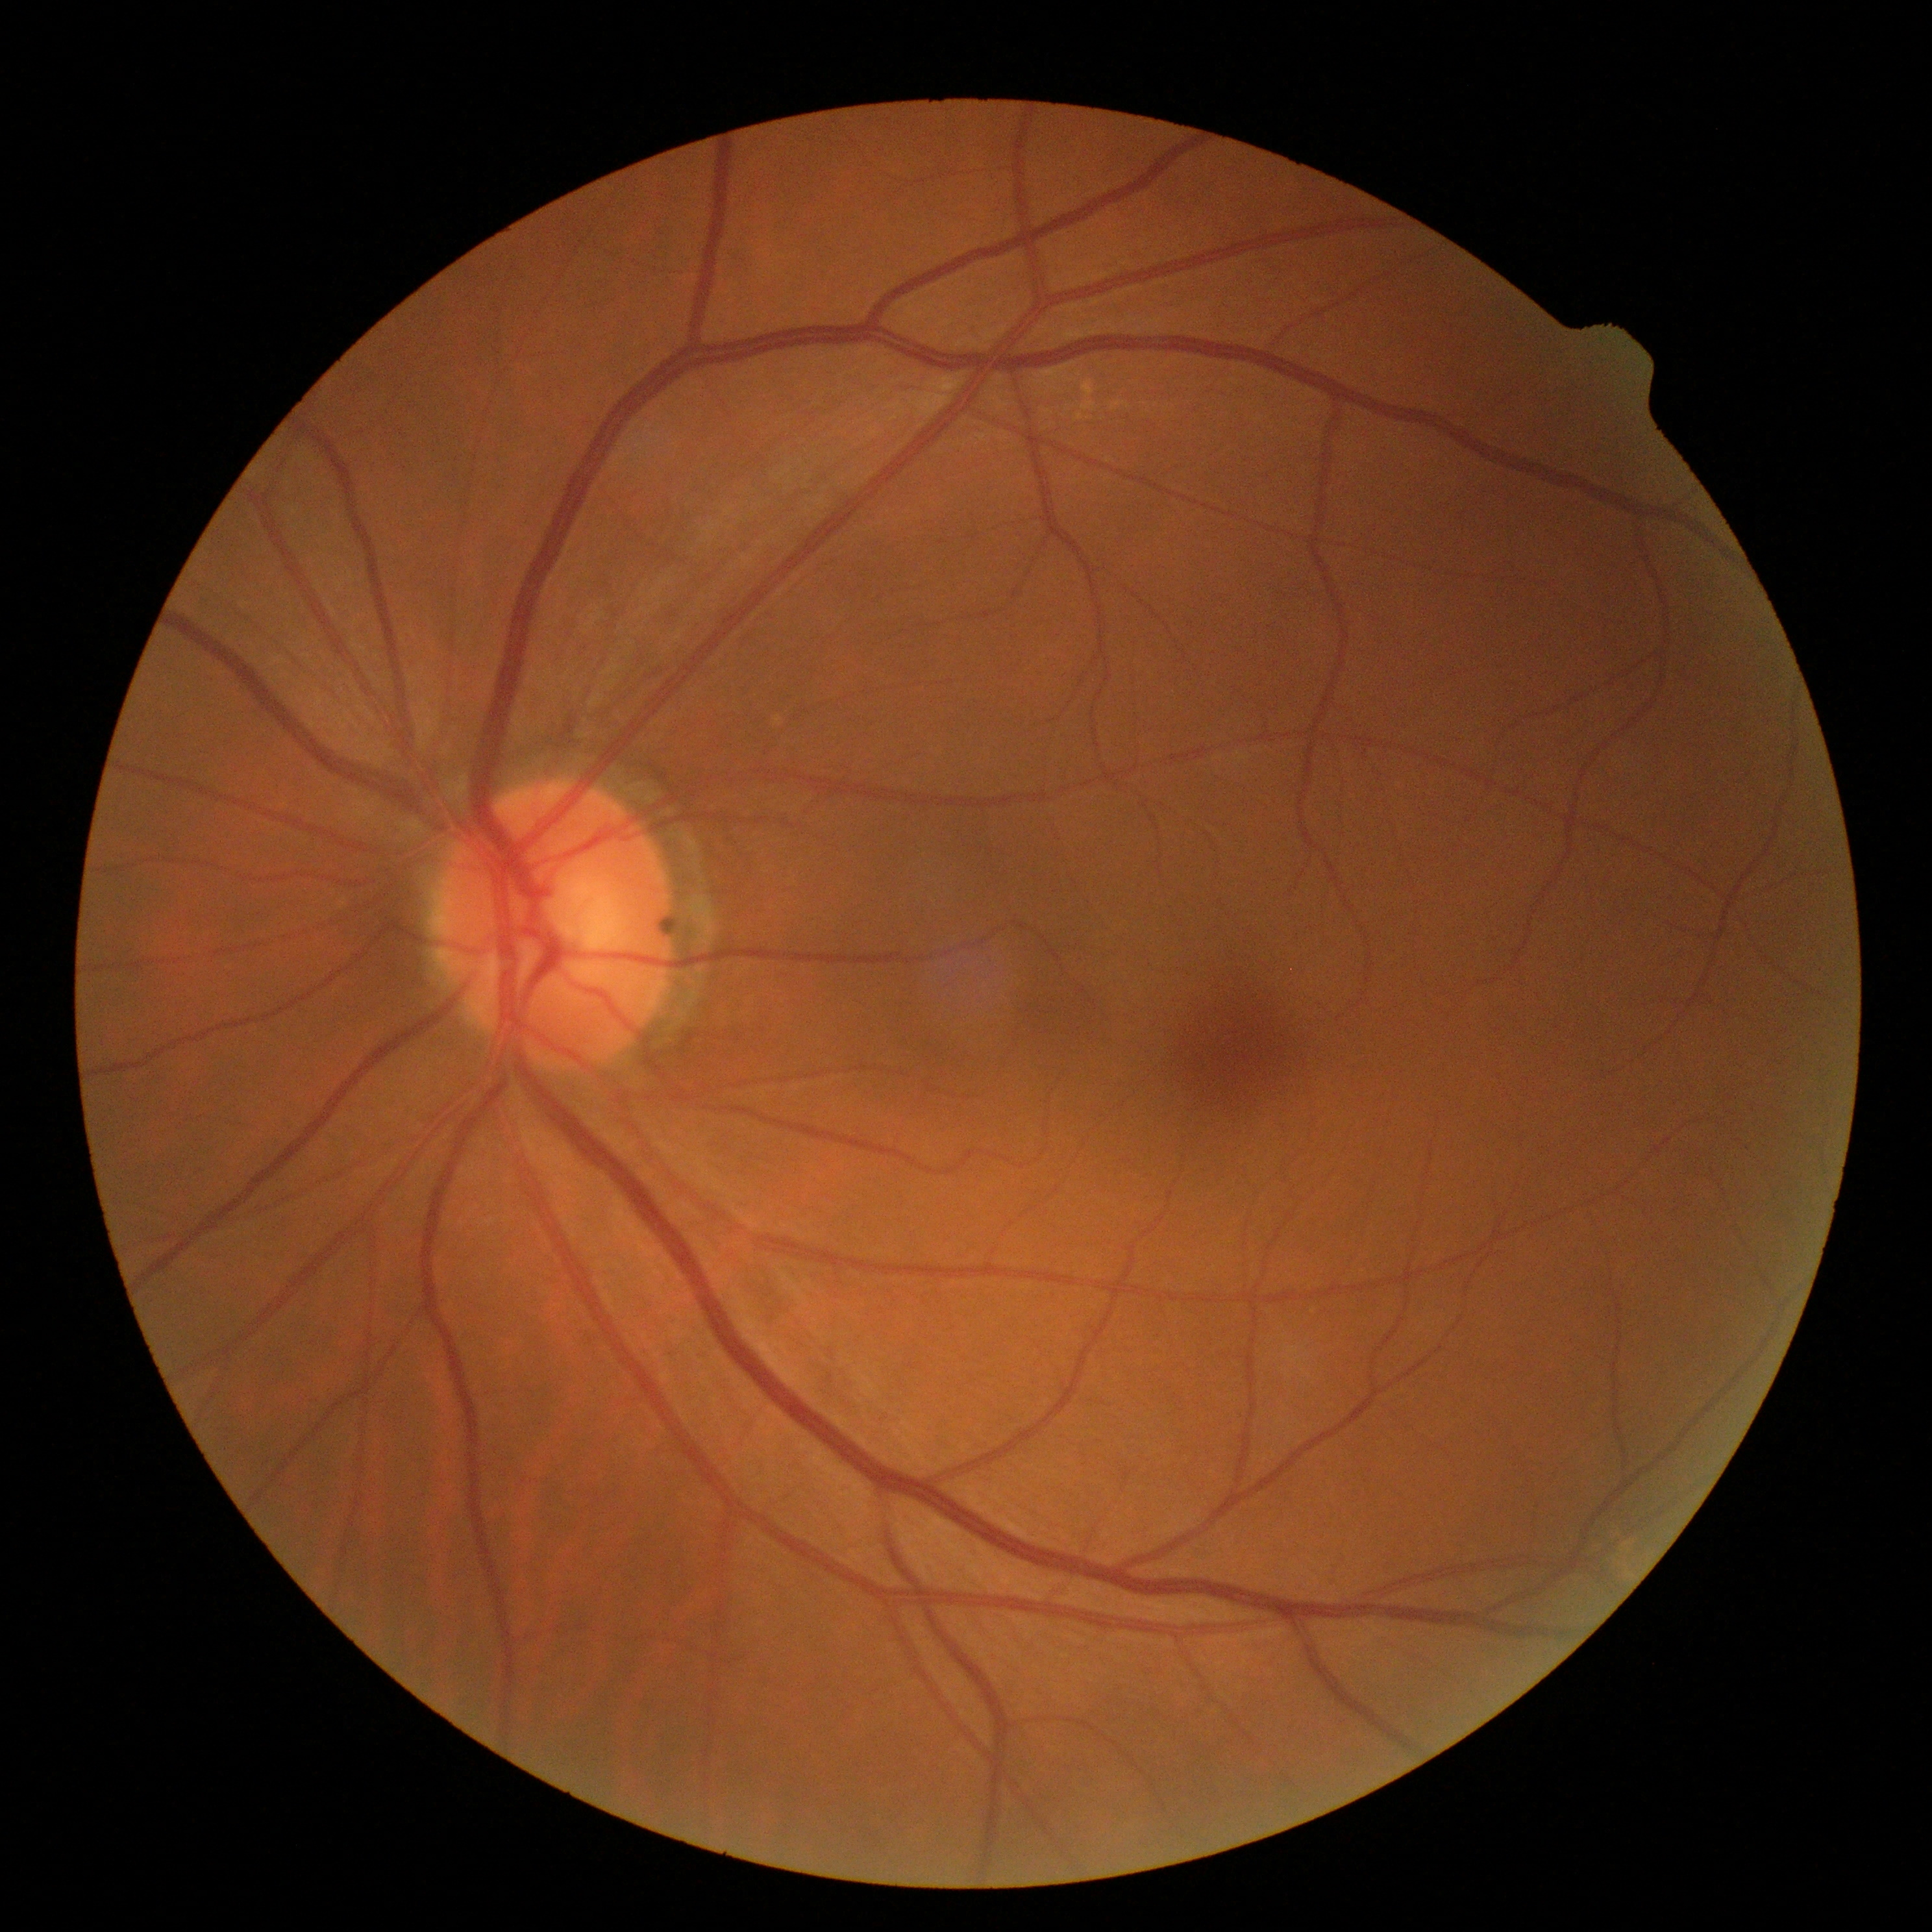
DR: 0 — no visible signs of diabetic retinopathy. No apparent diabetic retinopathy.